Pediatric wide-field fundus photograph — 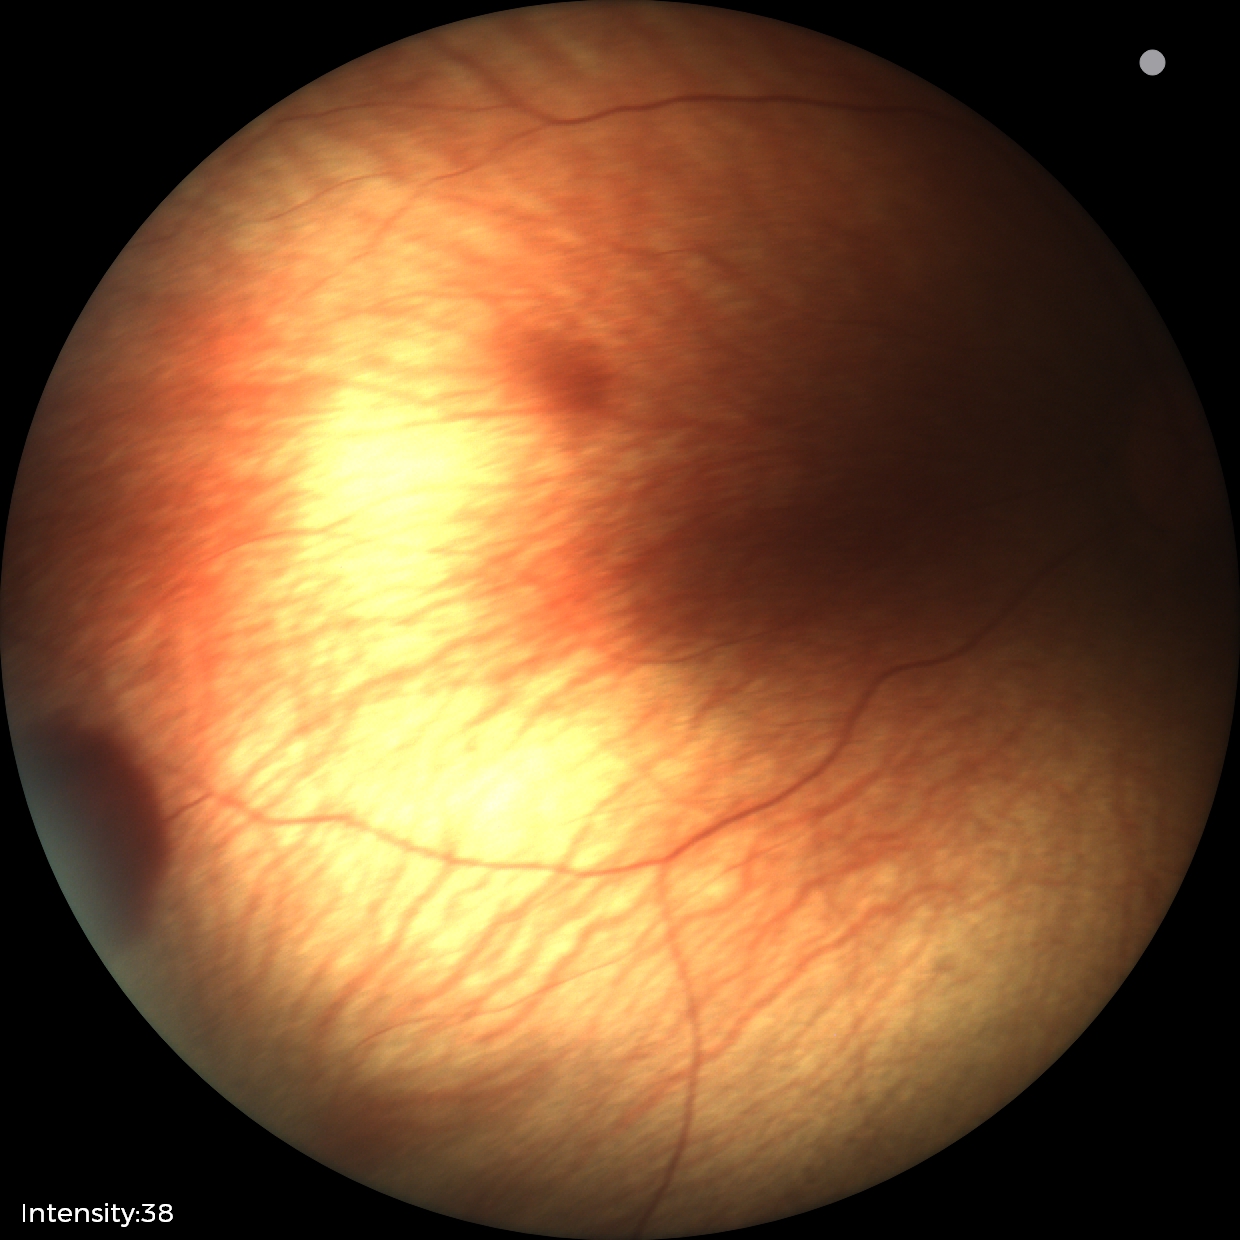
Assessment = retinal hemorrhages